Camera: Topcon TRC-NW8, macula at the center of the field
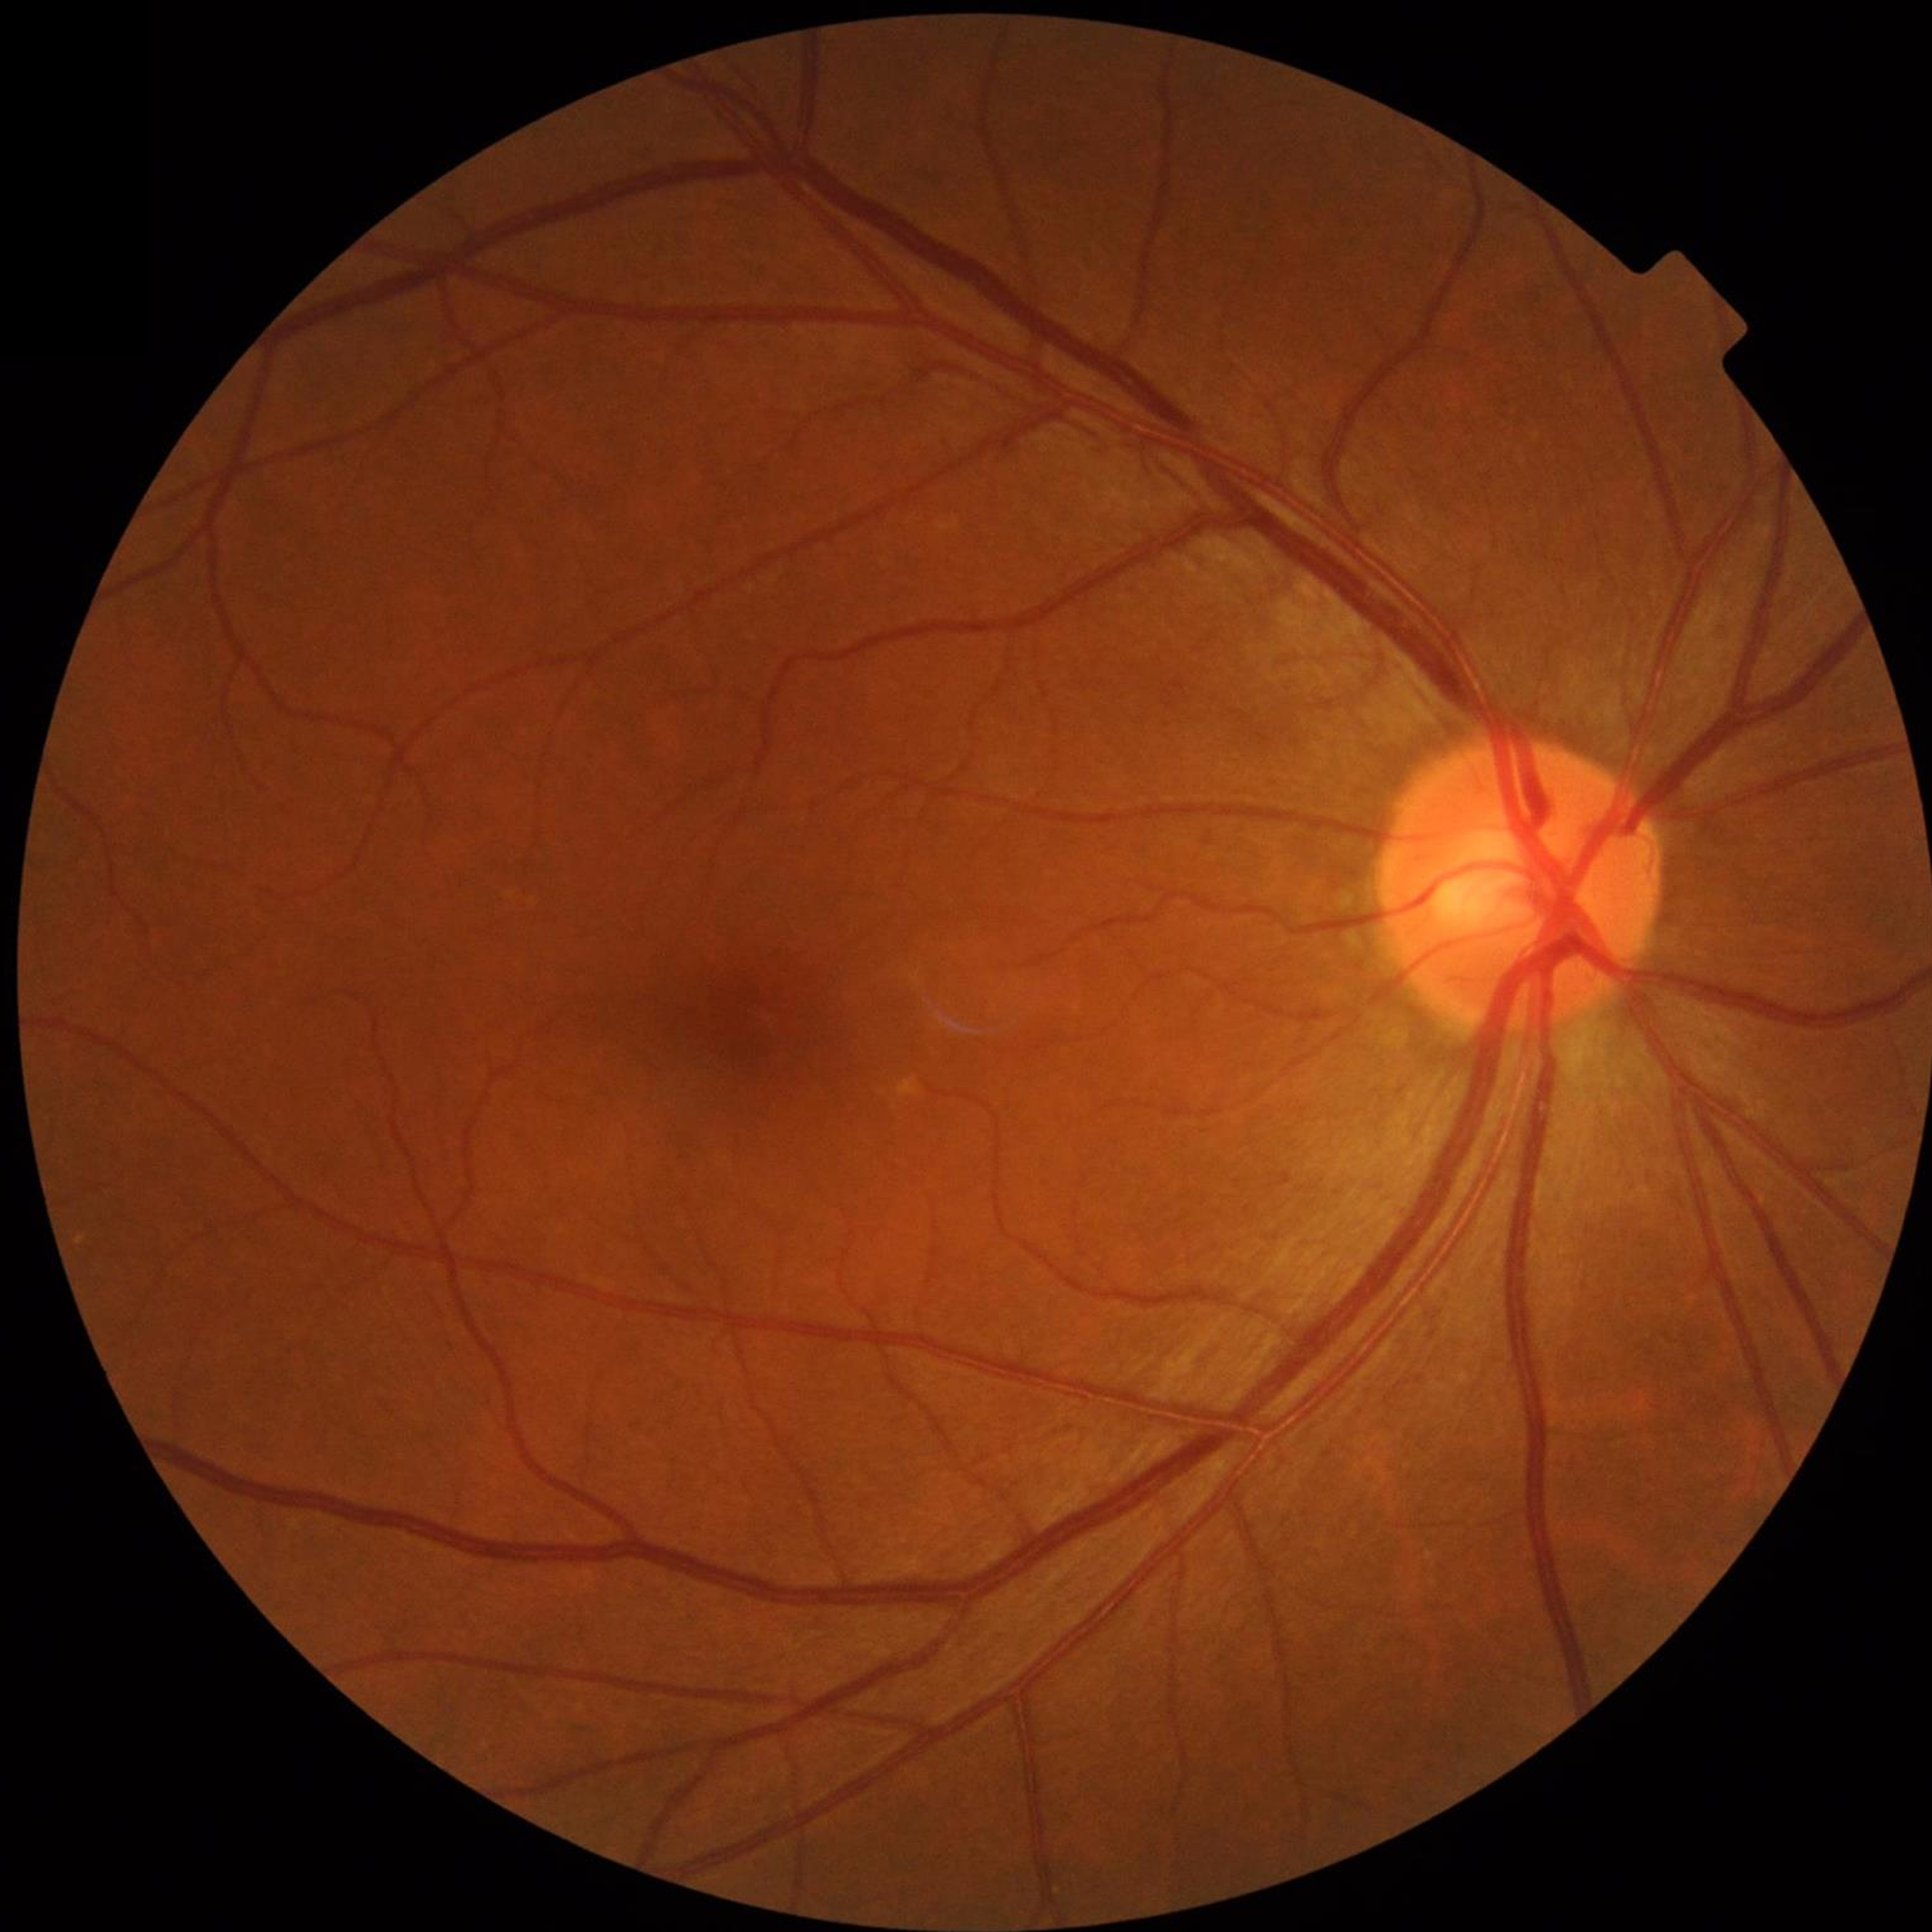

Condition = no AMD, diabetic retinopathy, or glaucoma
Quality = adequate